Retinal fundus photograph:
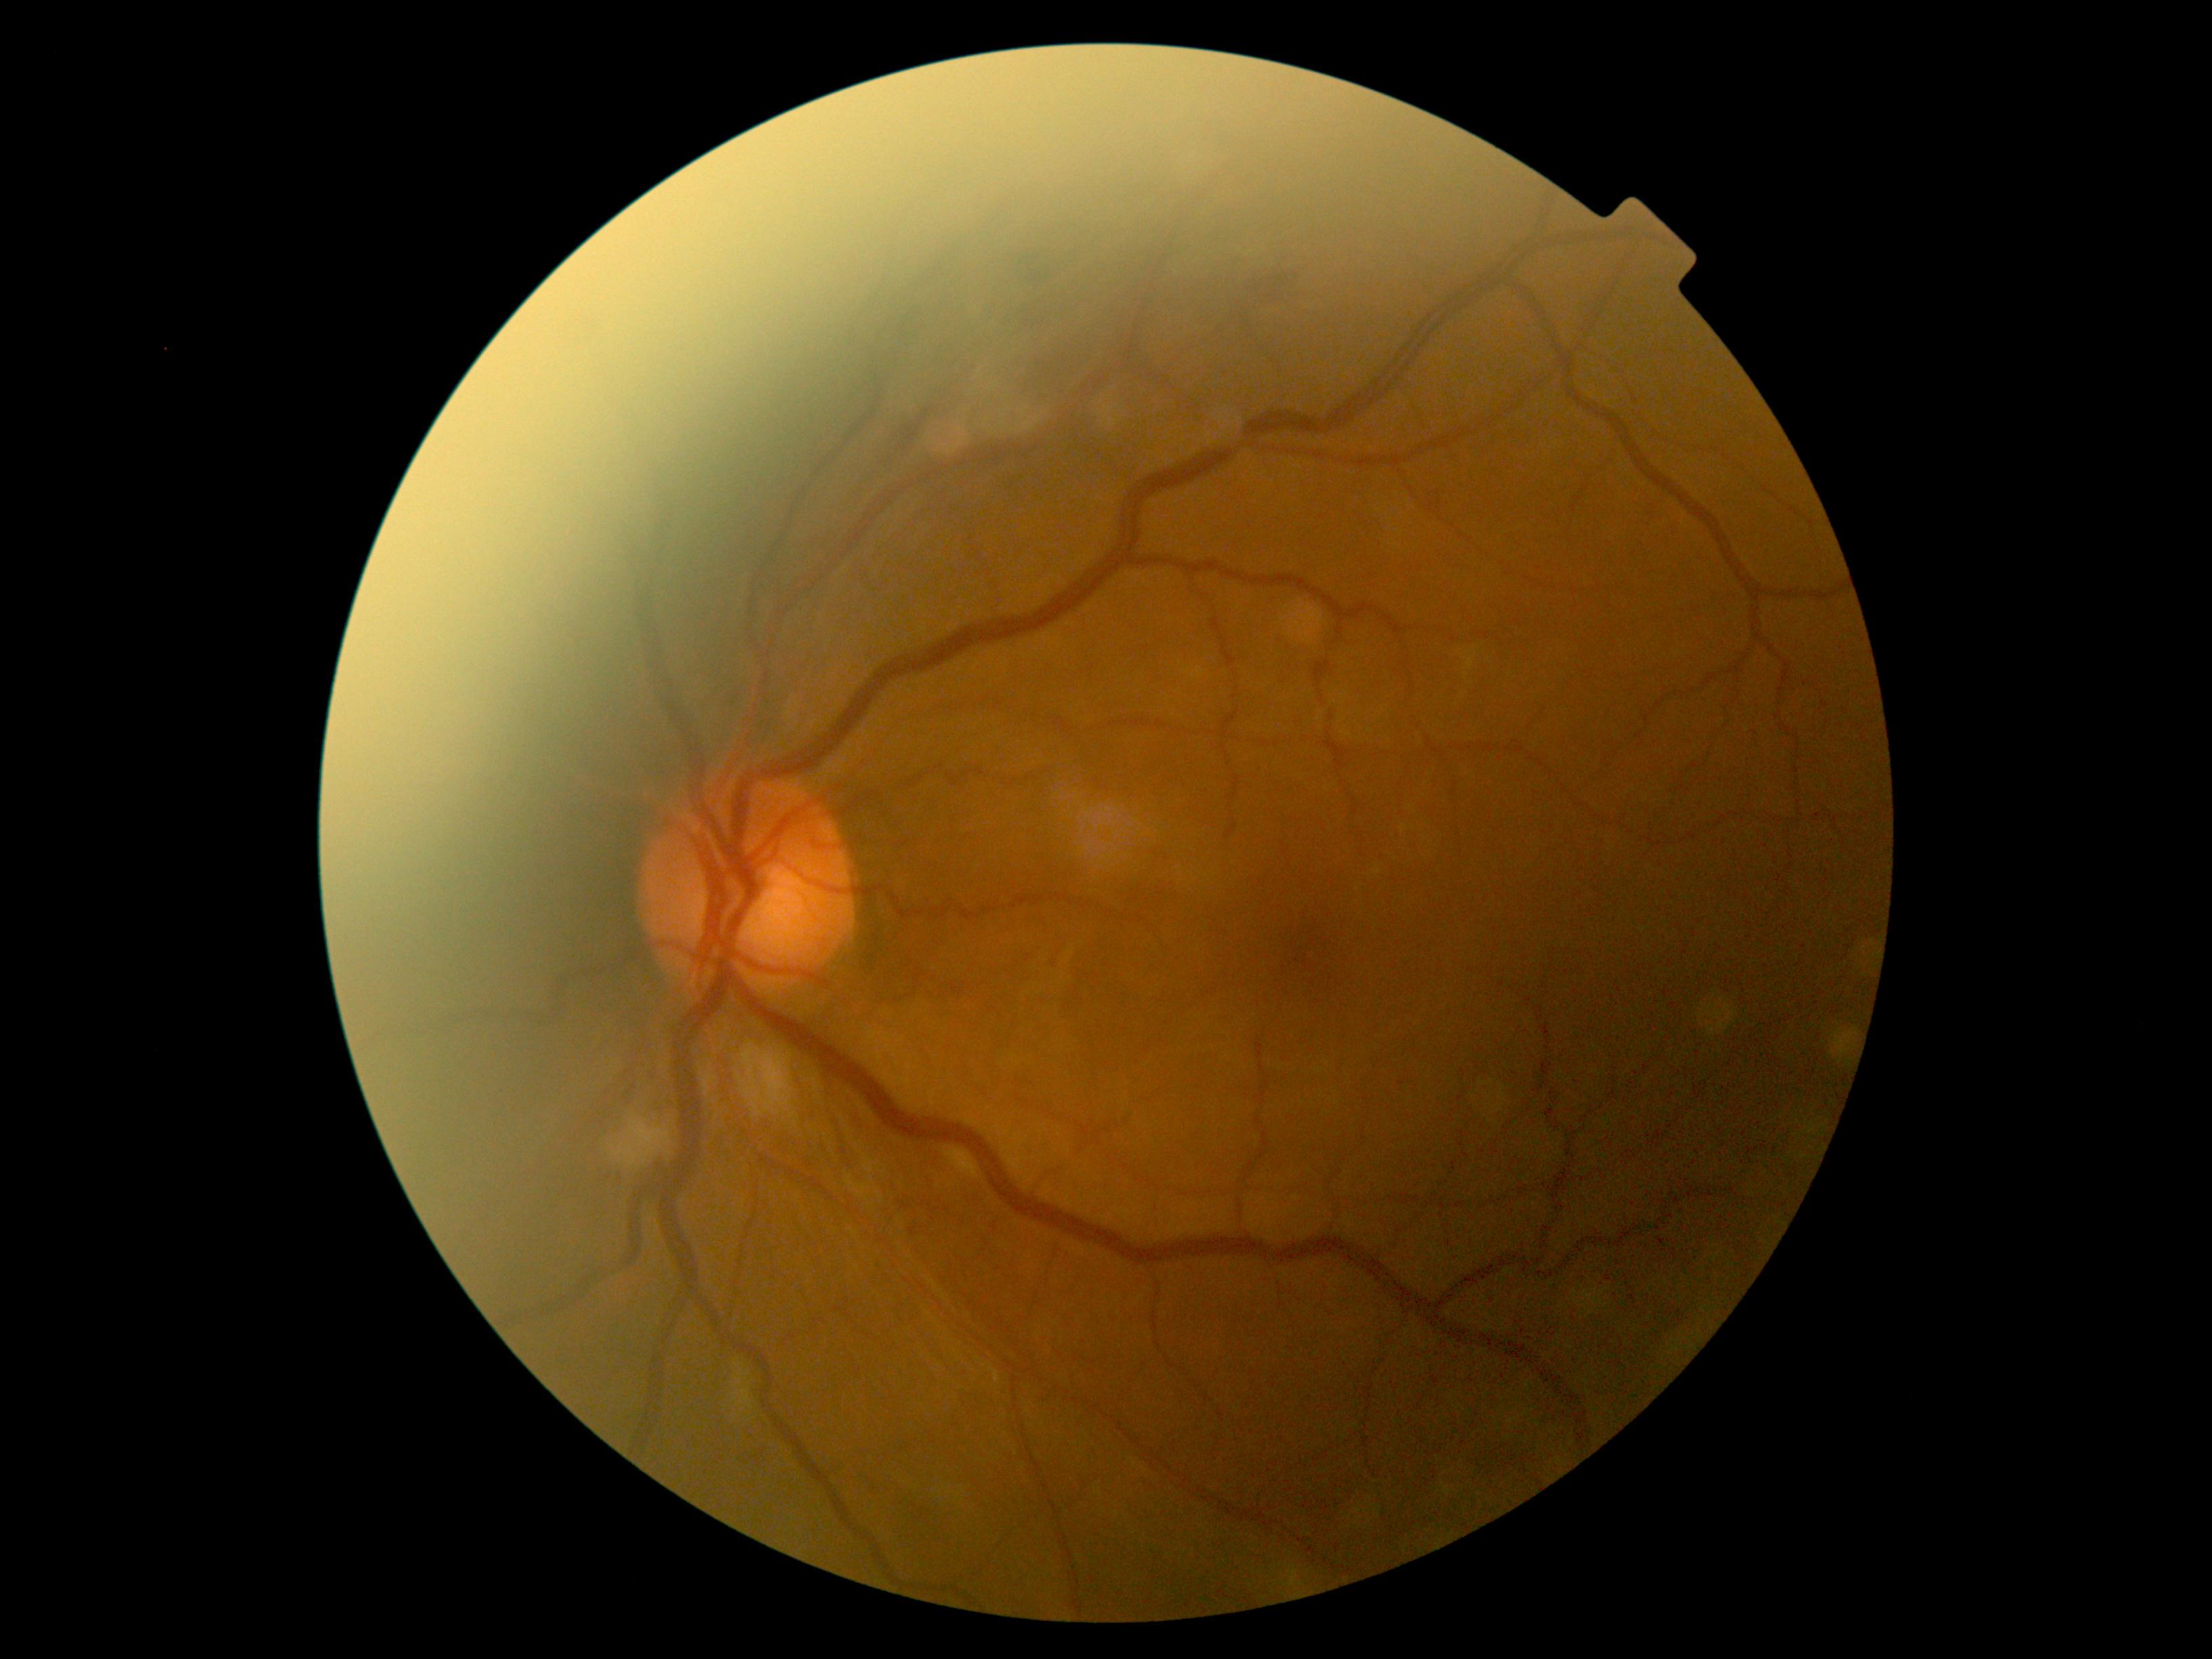

- DR: grade 2 (moderate NPDR)